1725x1721px. Color fundus photograph: 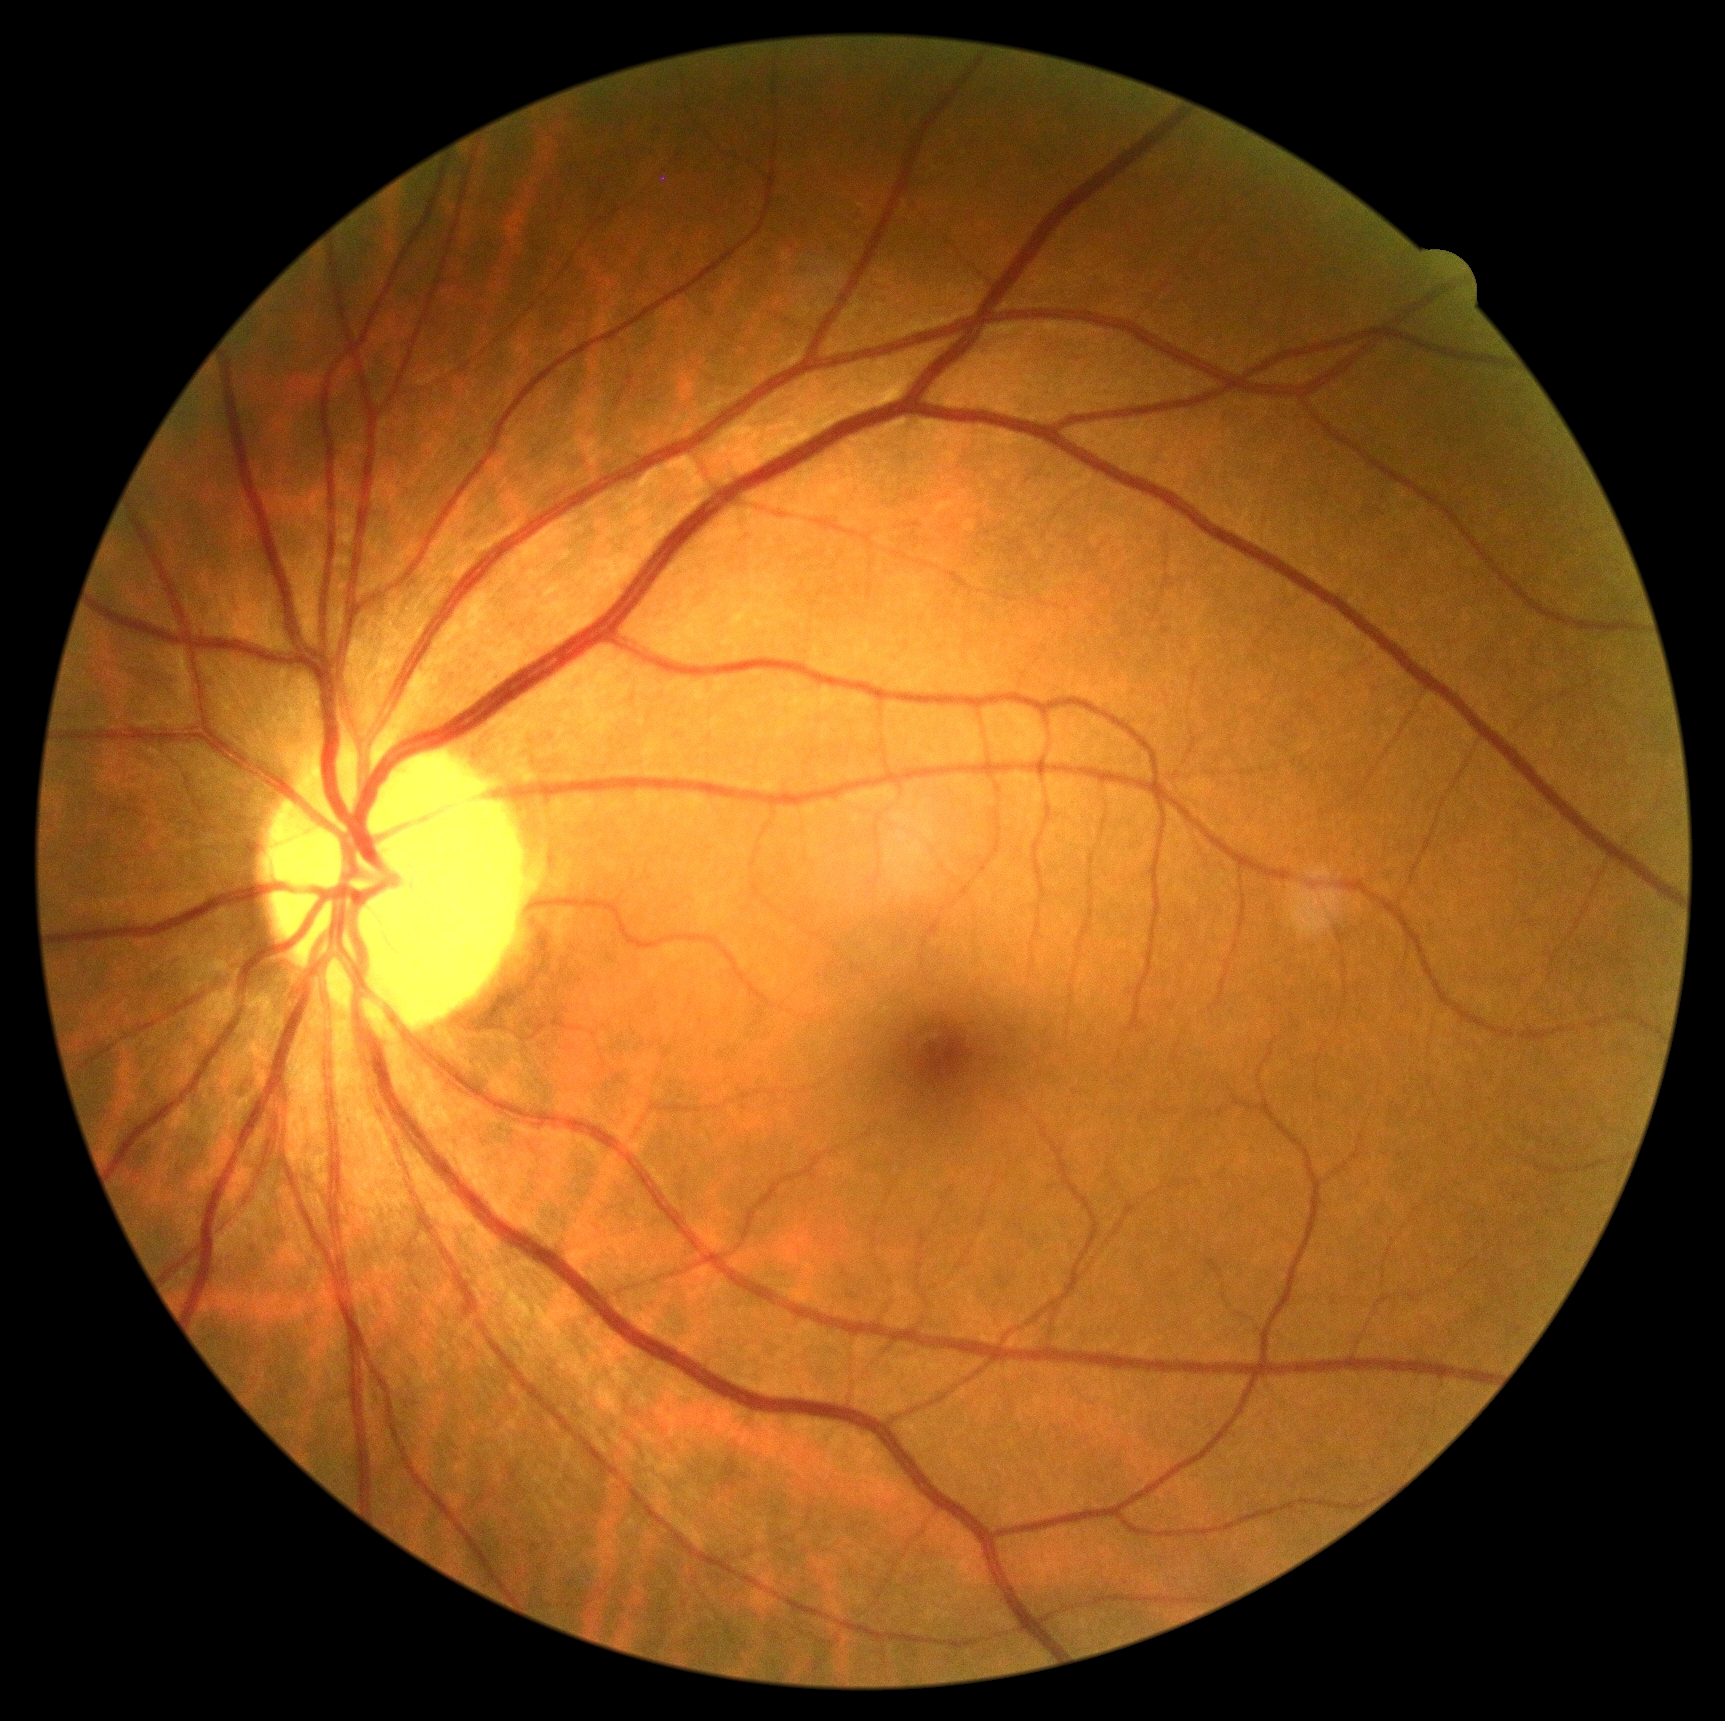

DR severity: no apparent diabetic retinopathy (grade 0).